Wide-field contact fundus photograph of an infant: 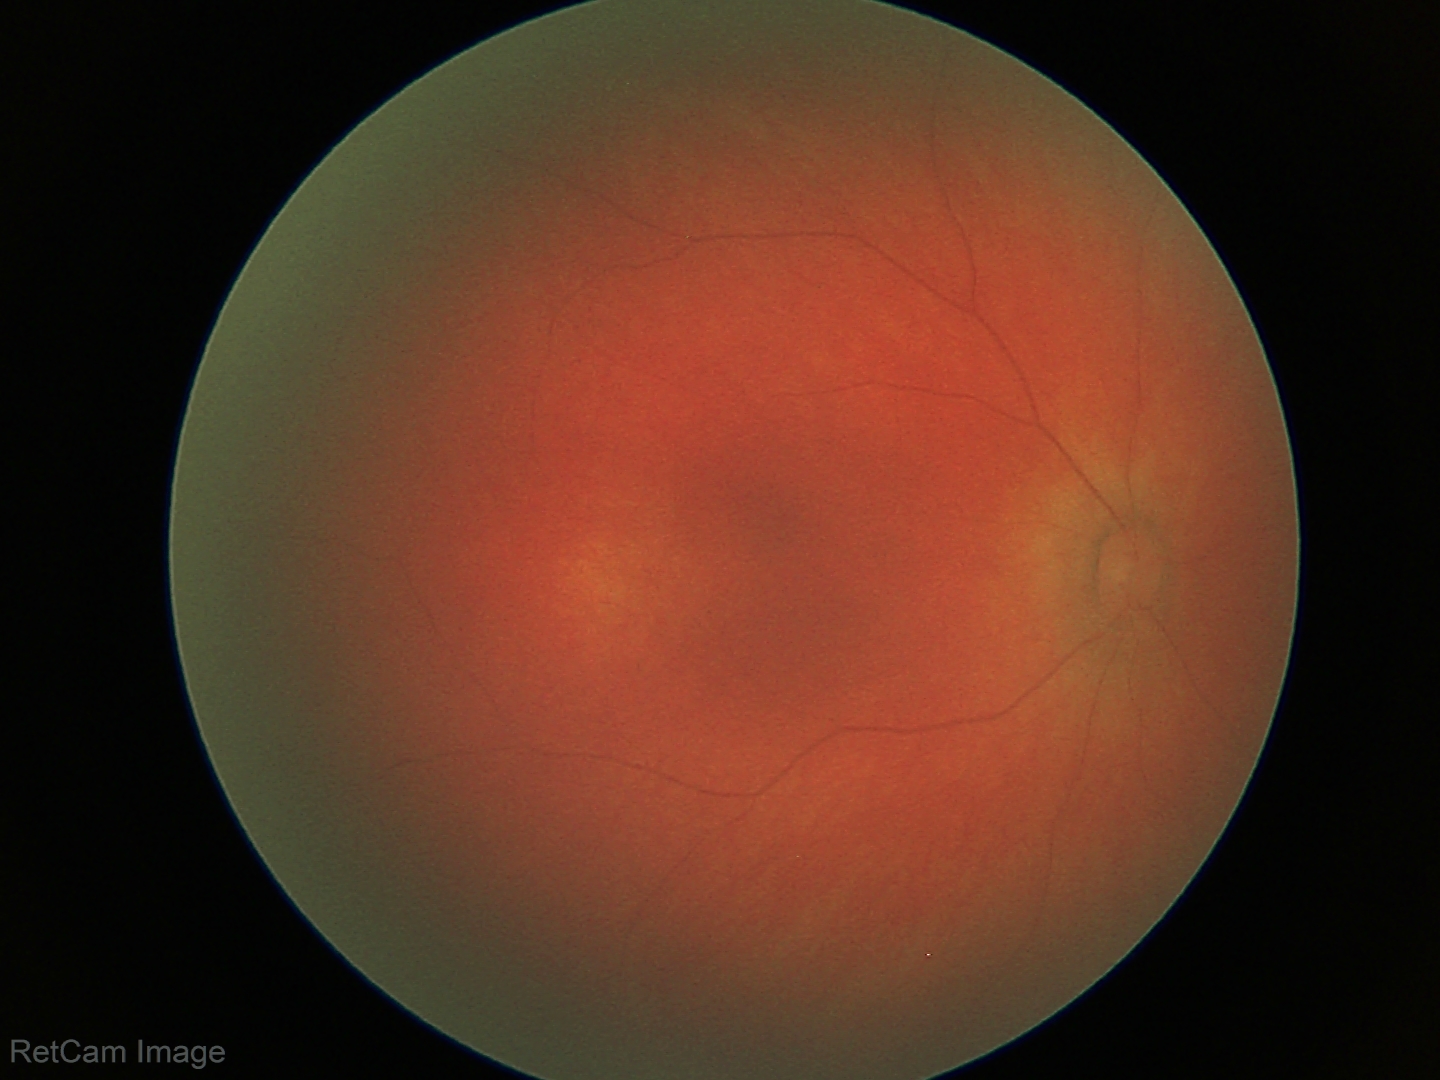

Finding: normal